No pharmacologic dilation · posterior pole photograph · NIDEK AFC-230 fundus camera · 848 x 848 pixels:
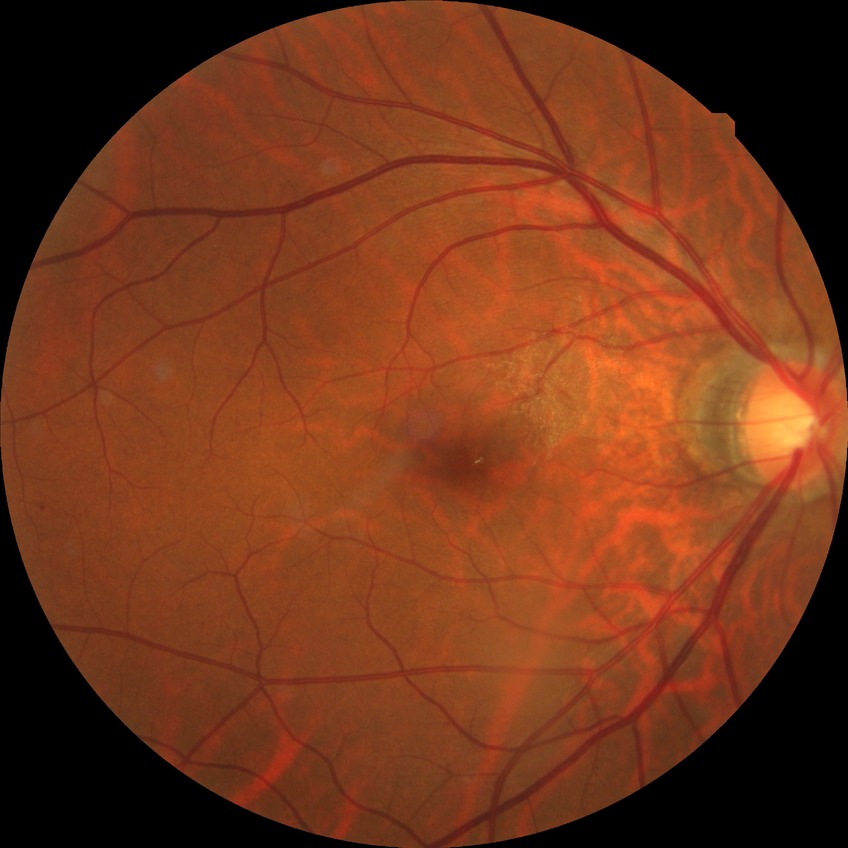 diabetic retinopathy severity = simple diabetic retinopathy.